848x848px
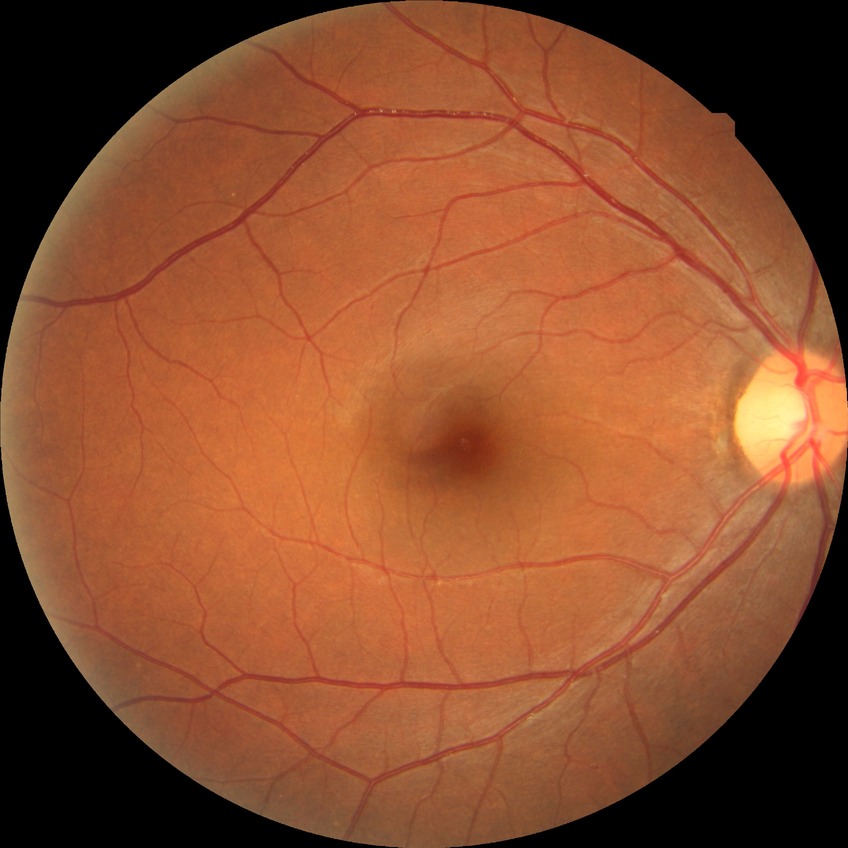 Diabetic retinopathy (DR): NDR (no diabetic retinopathy).